2352x1568:
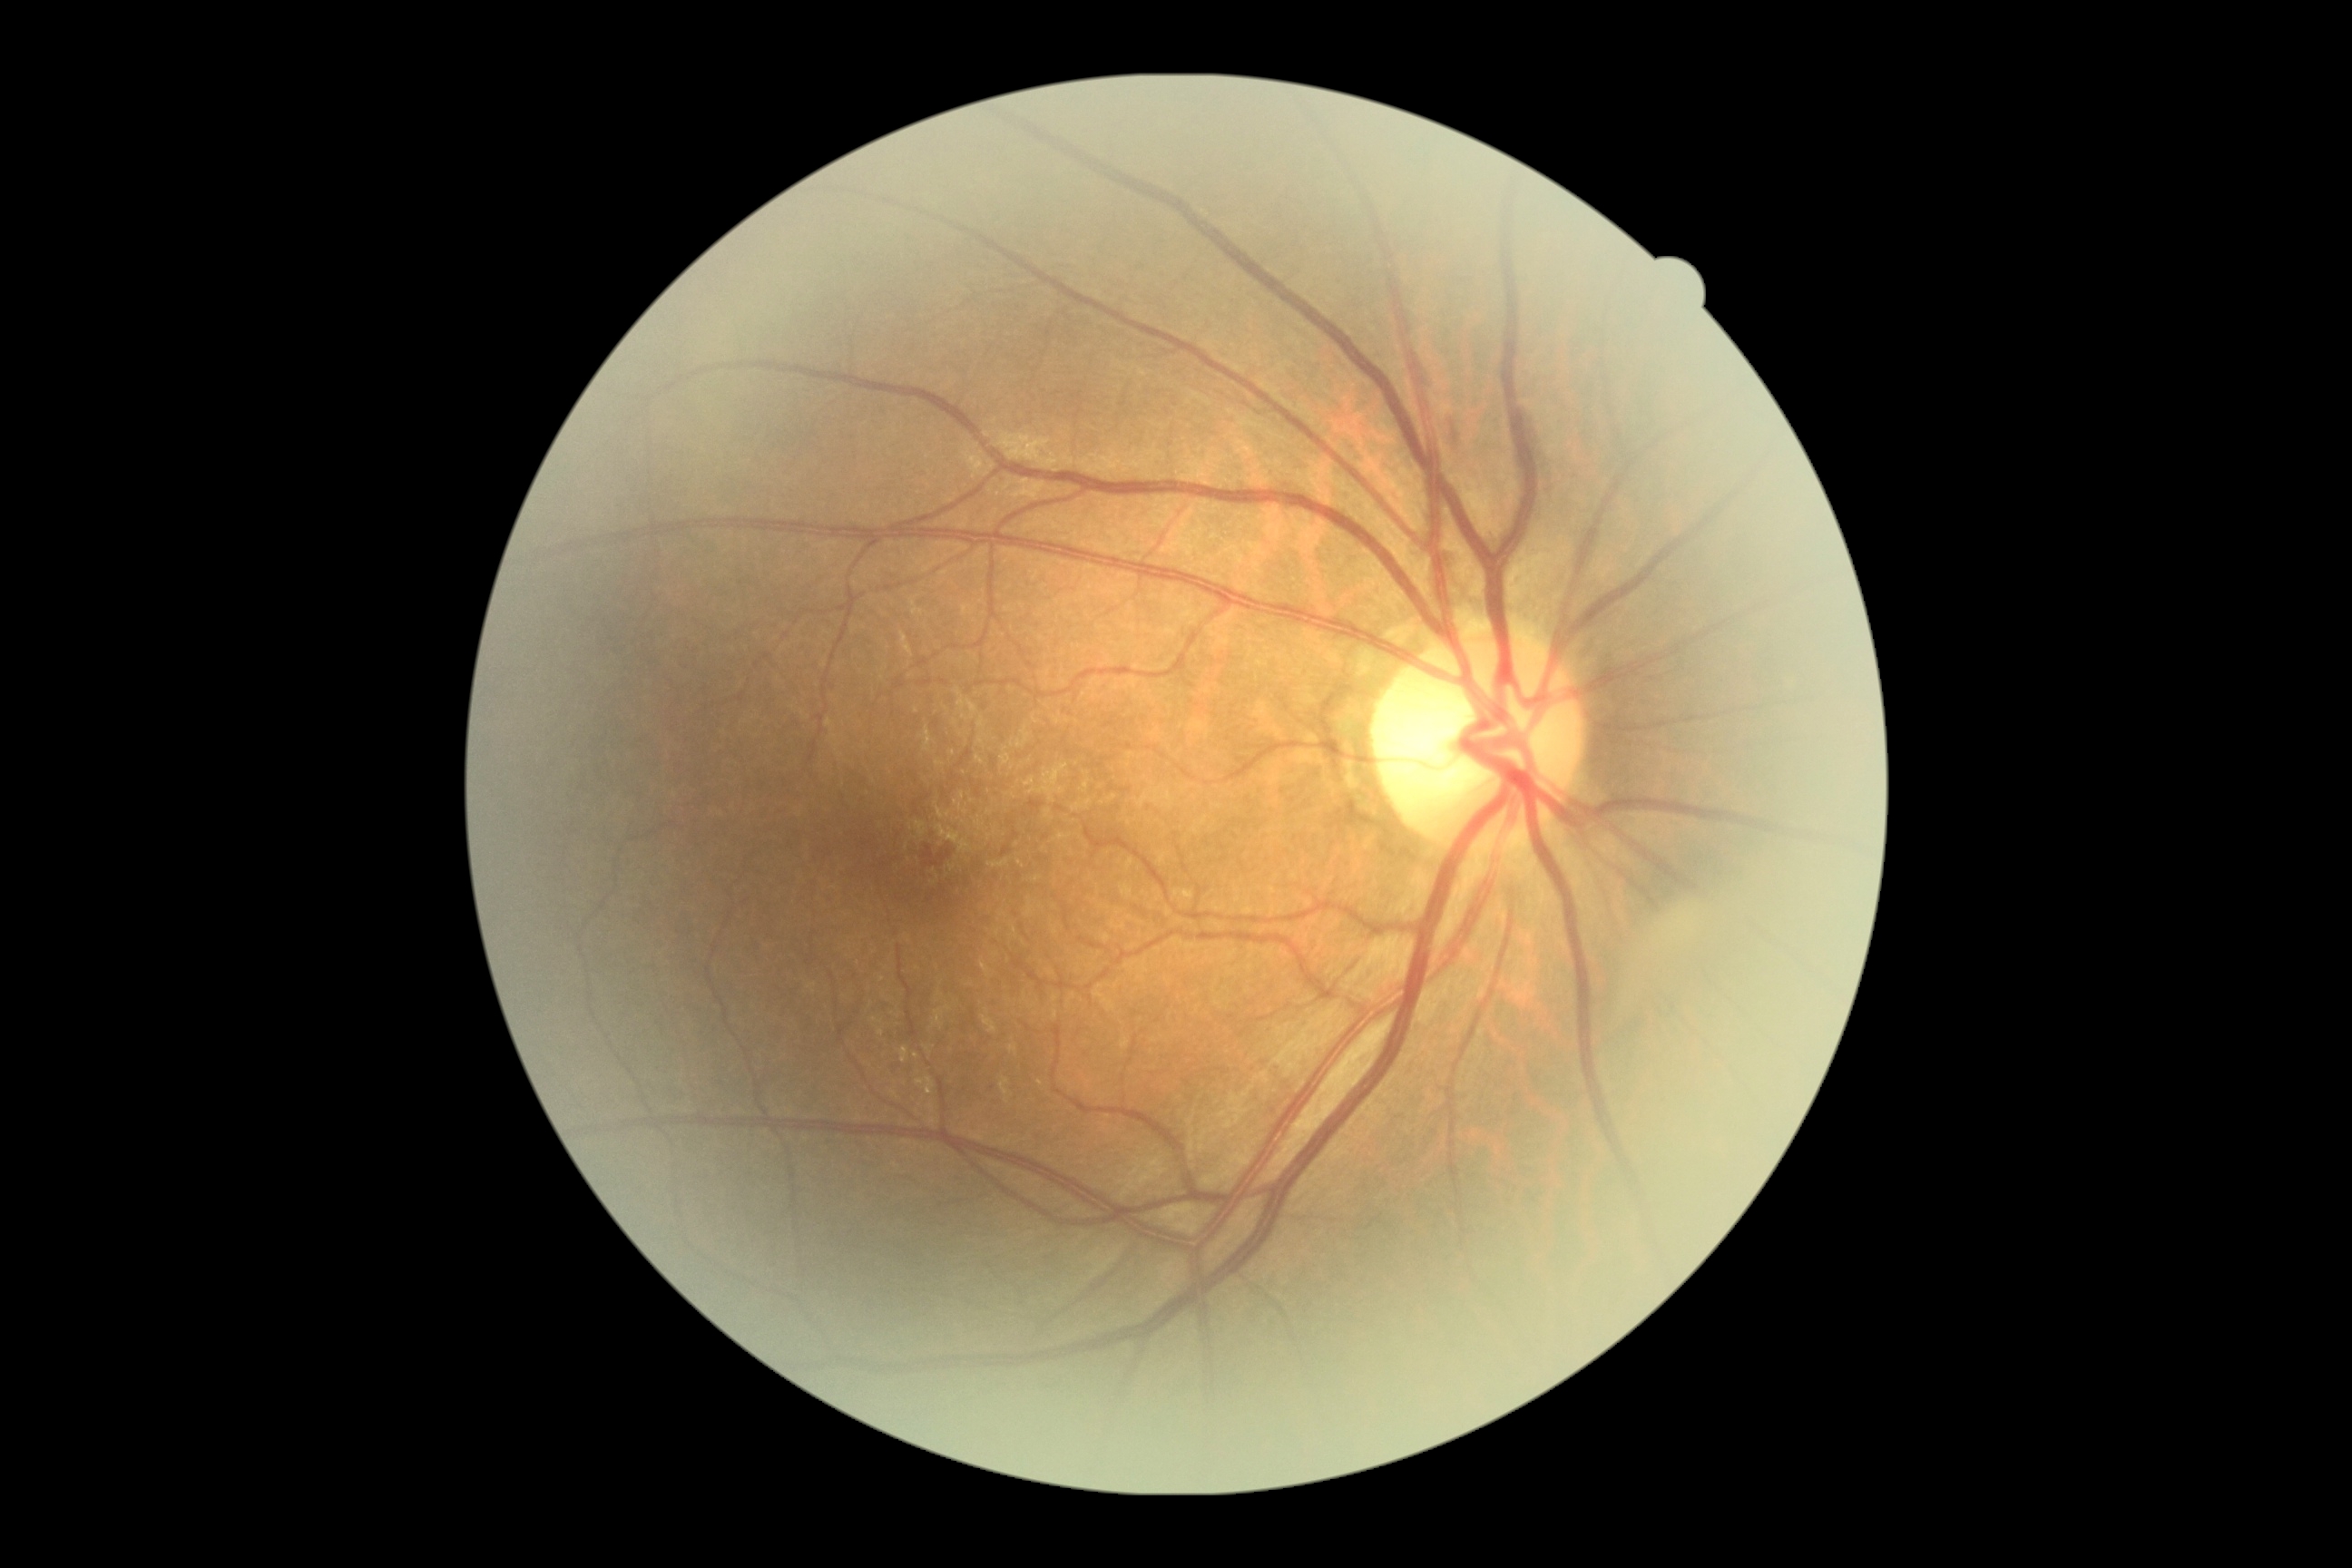

DR grade: 2/4.